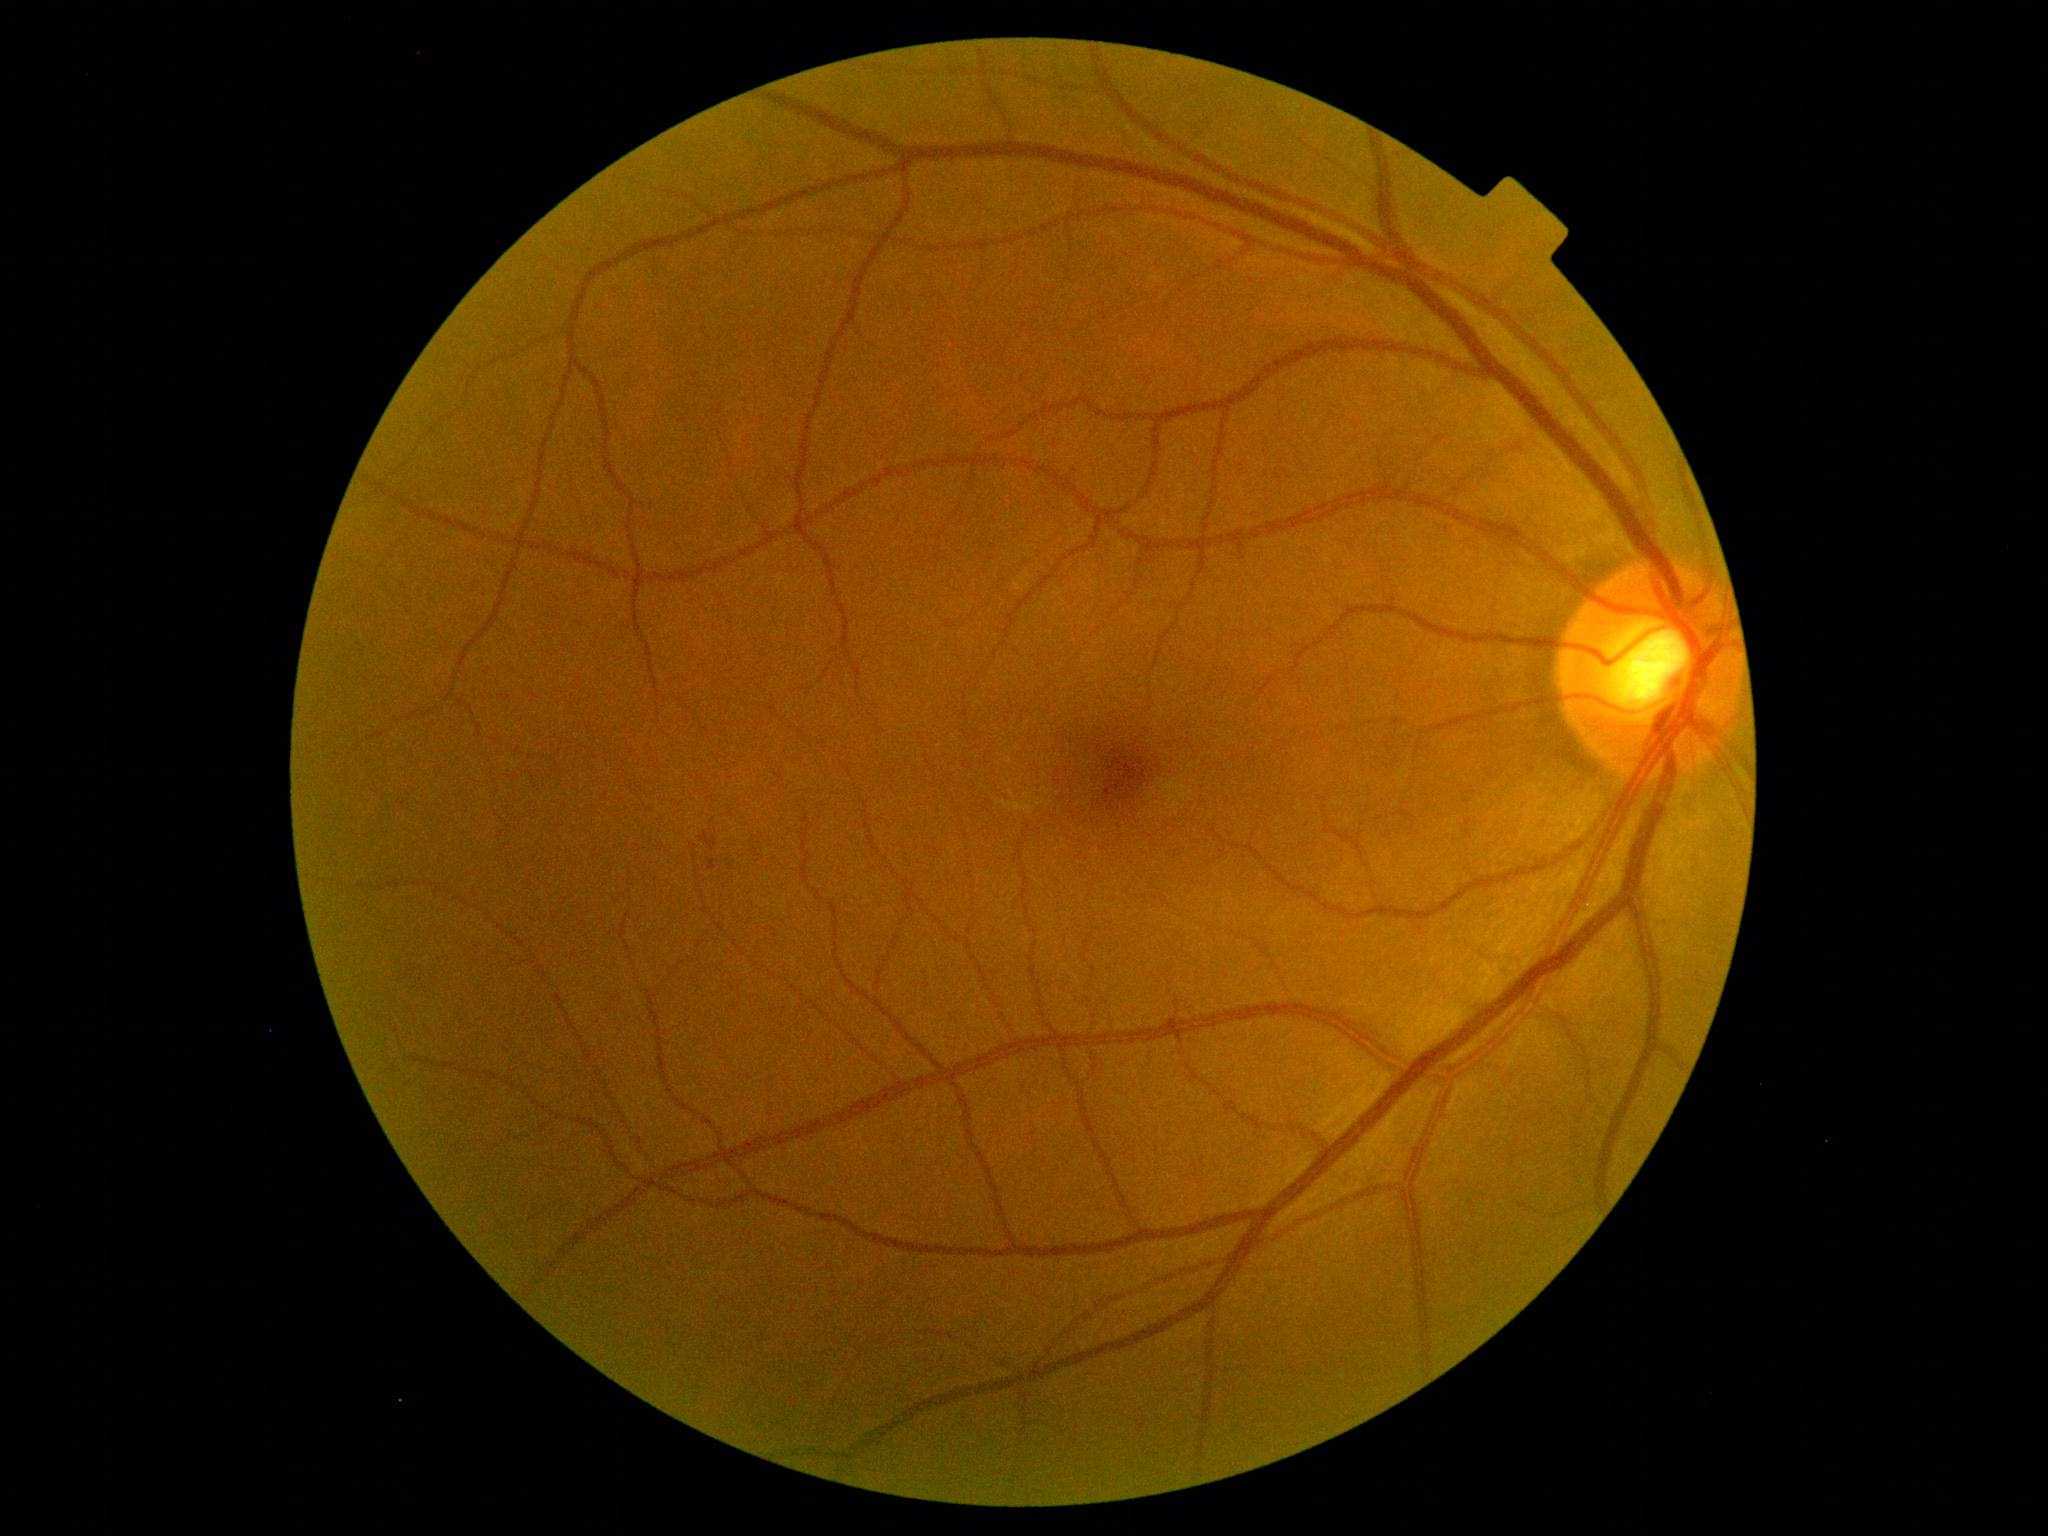
diabetic retinopathy severity=grade 1 (mild NPDR).